Image size 1240x1240; wide-field fundus photograph of an infant; captured with the Phoenix ICON (100° field of view).
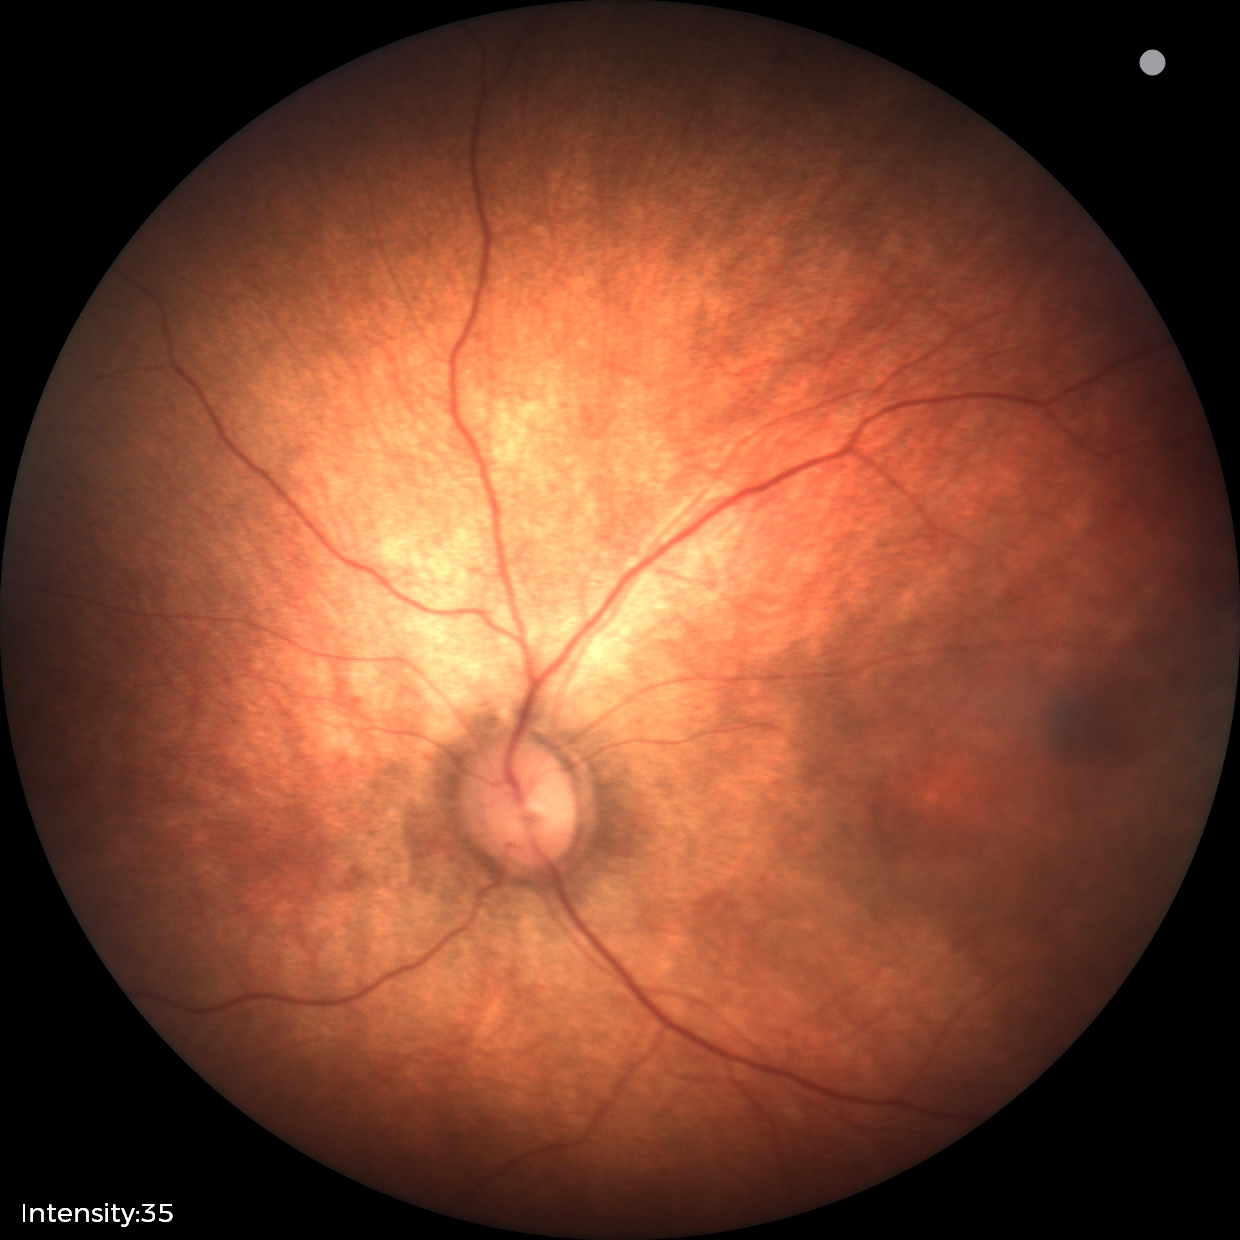

Finding: normal